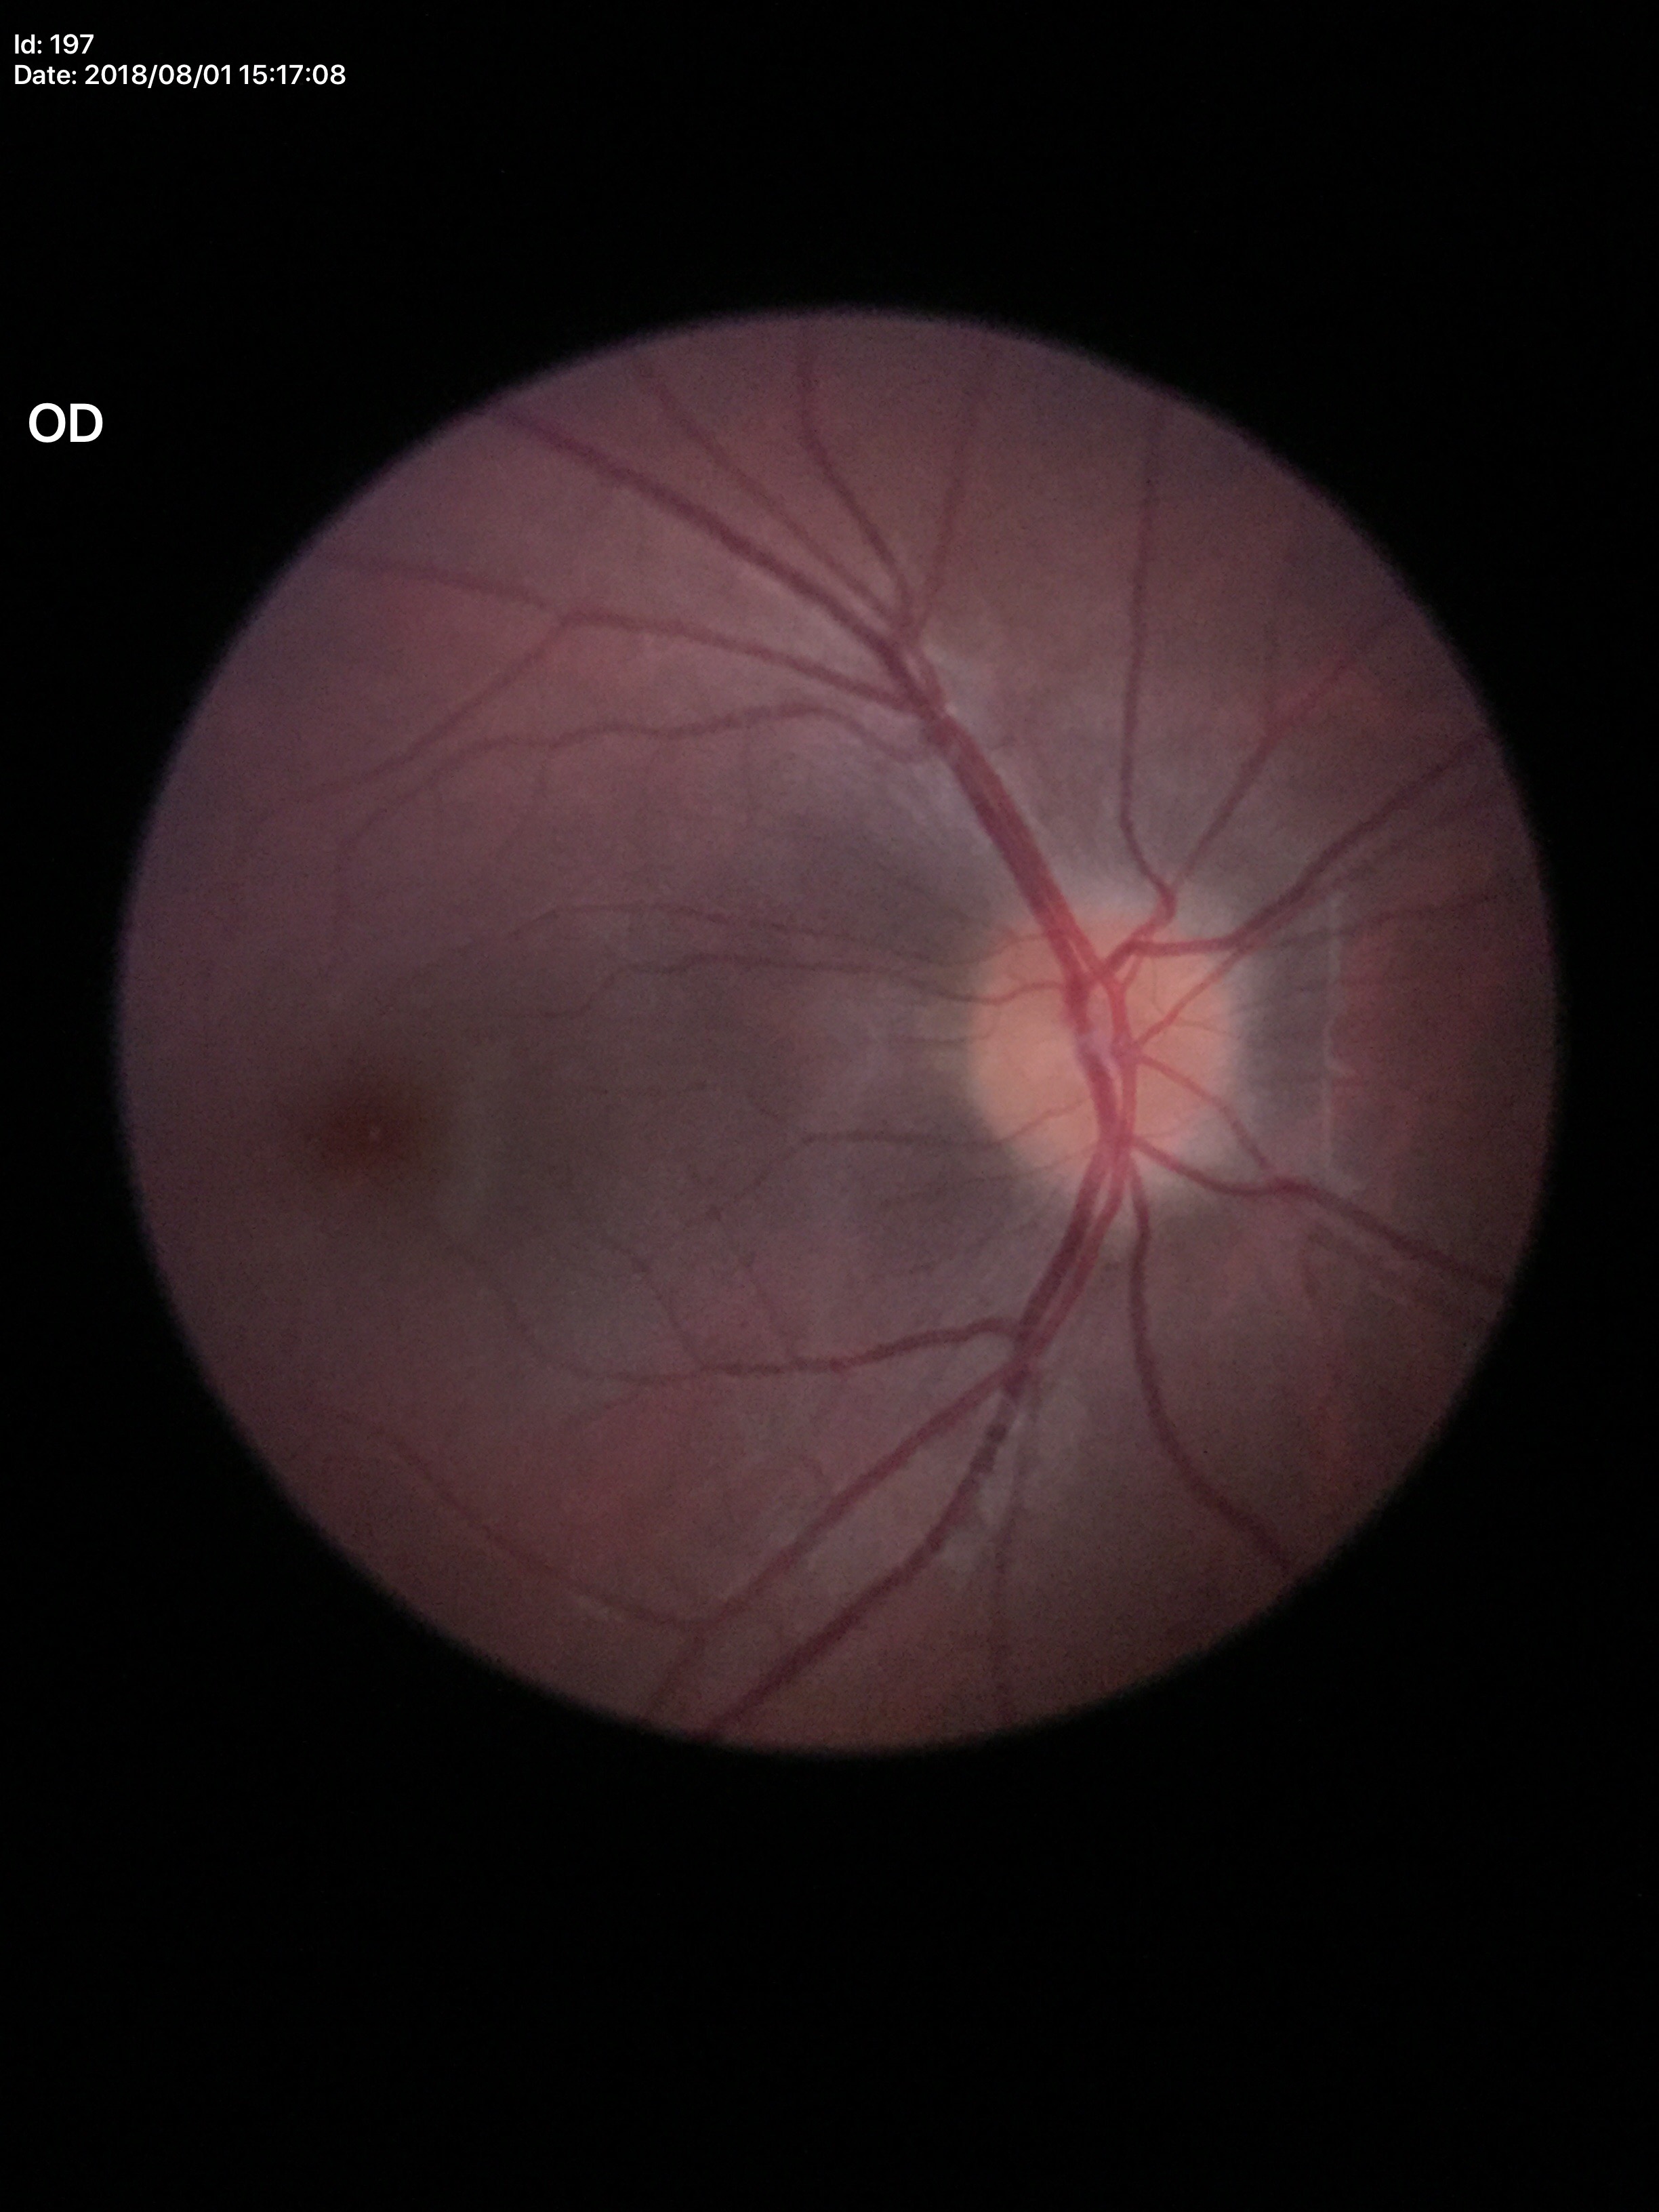

Glaucoma assessment: not suspect. VCDR: 0.40.